1240 x 1240 pixels; wide-field contact fundus photograph of an infant
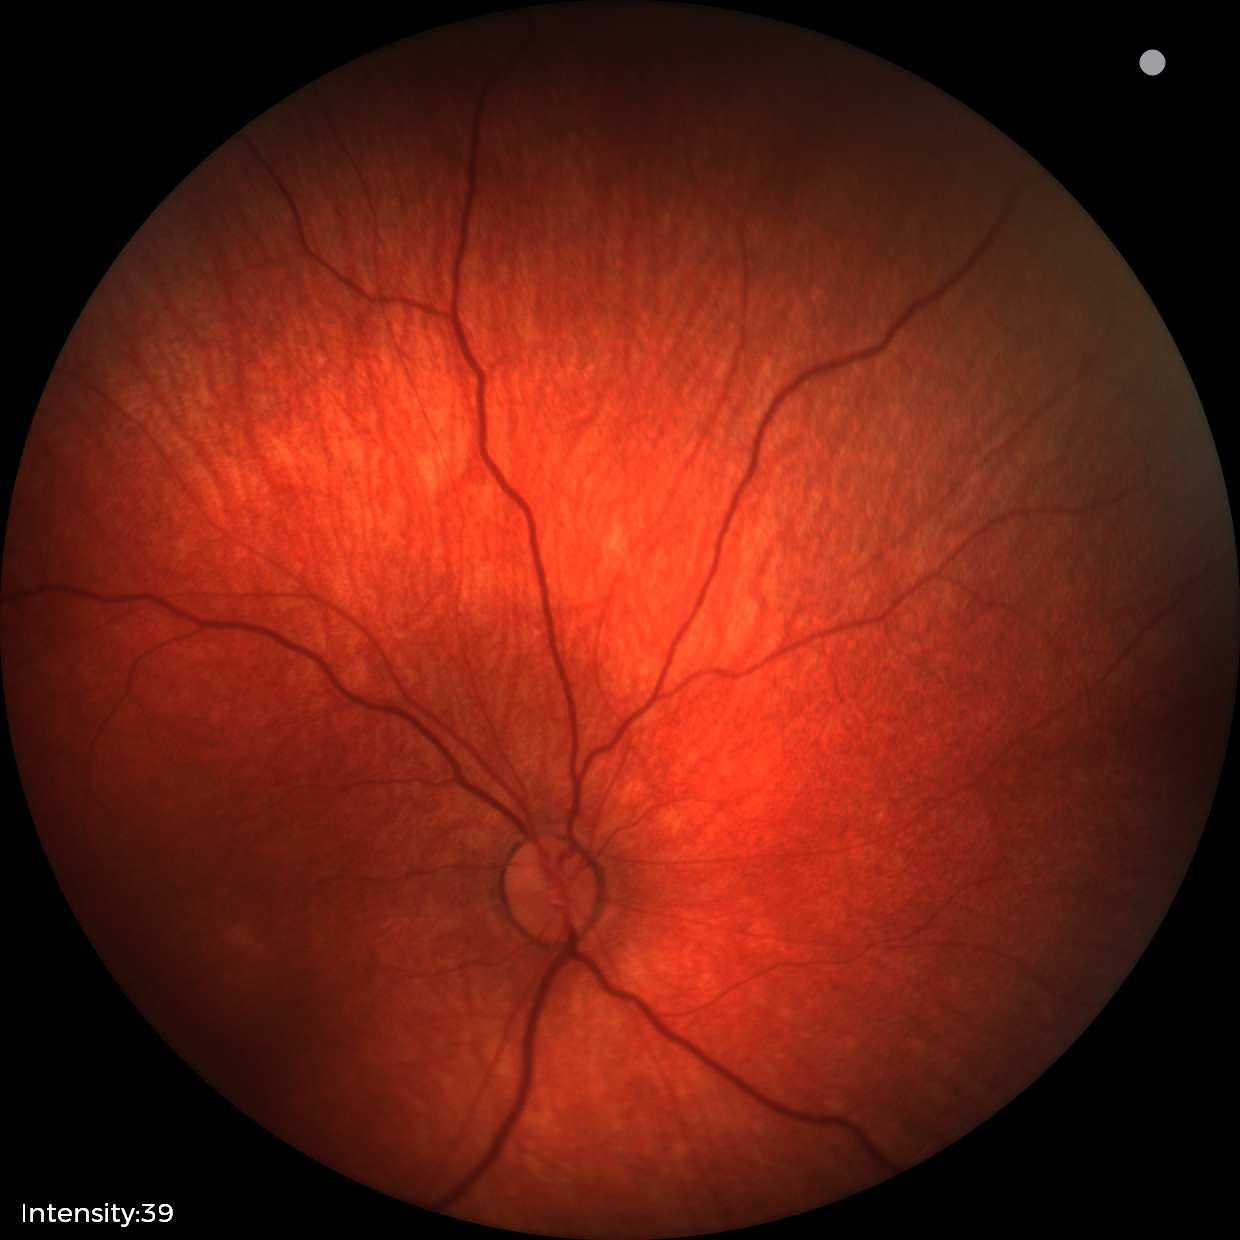
Q: What is the screening diagnosis?
A: normal retinal appearance